848x848px; 45° field of view — 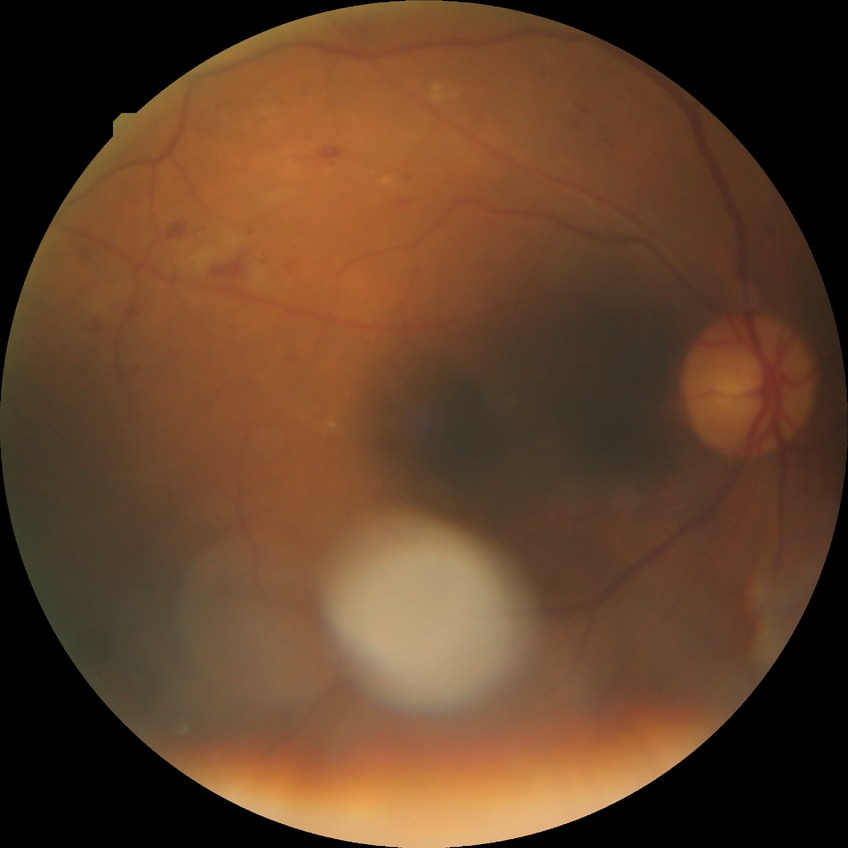 DR stage: PPDR. DR class: non-proliferative diabetic retinopathy.